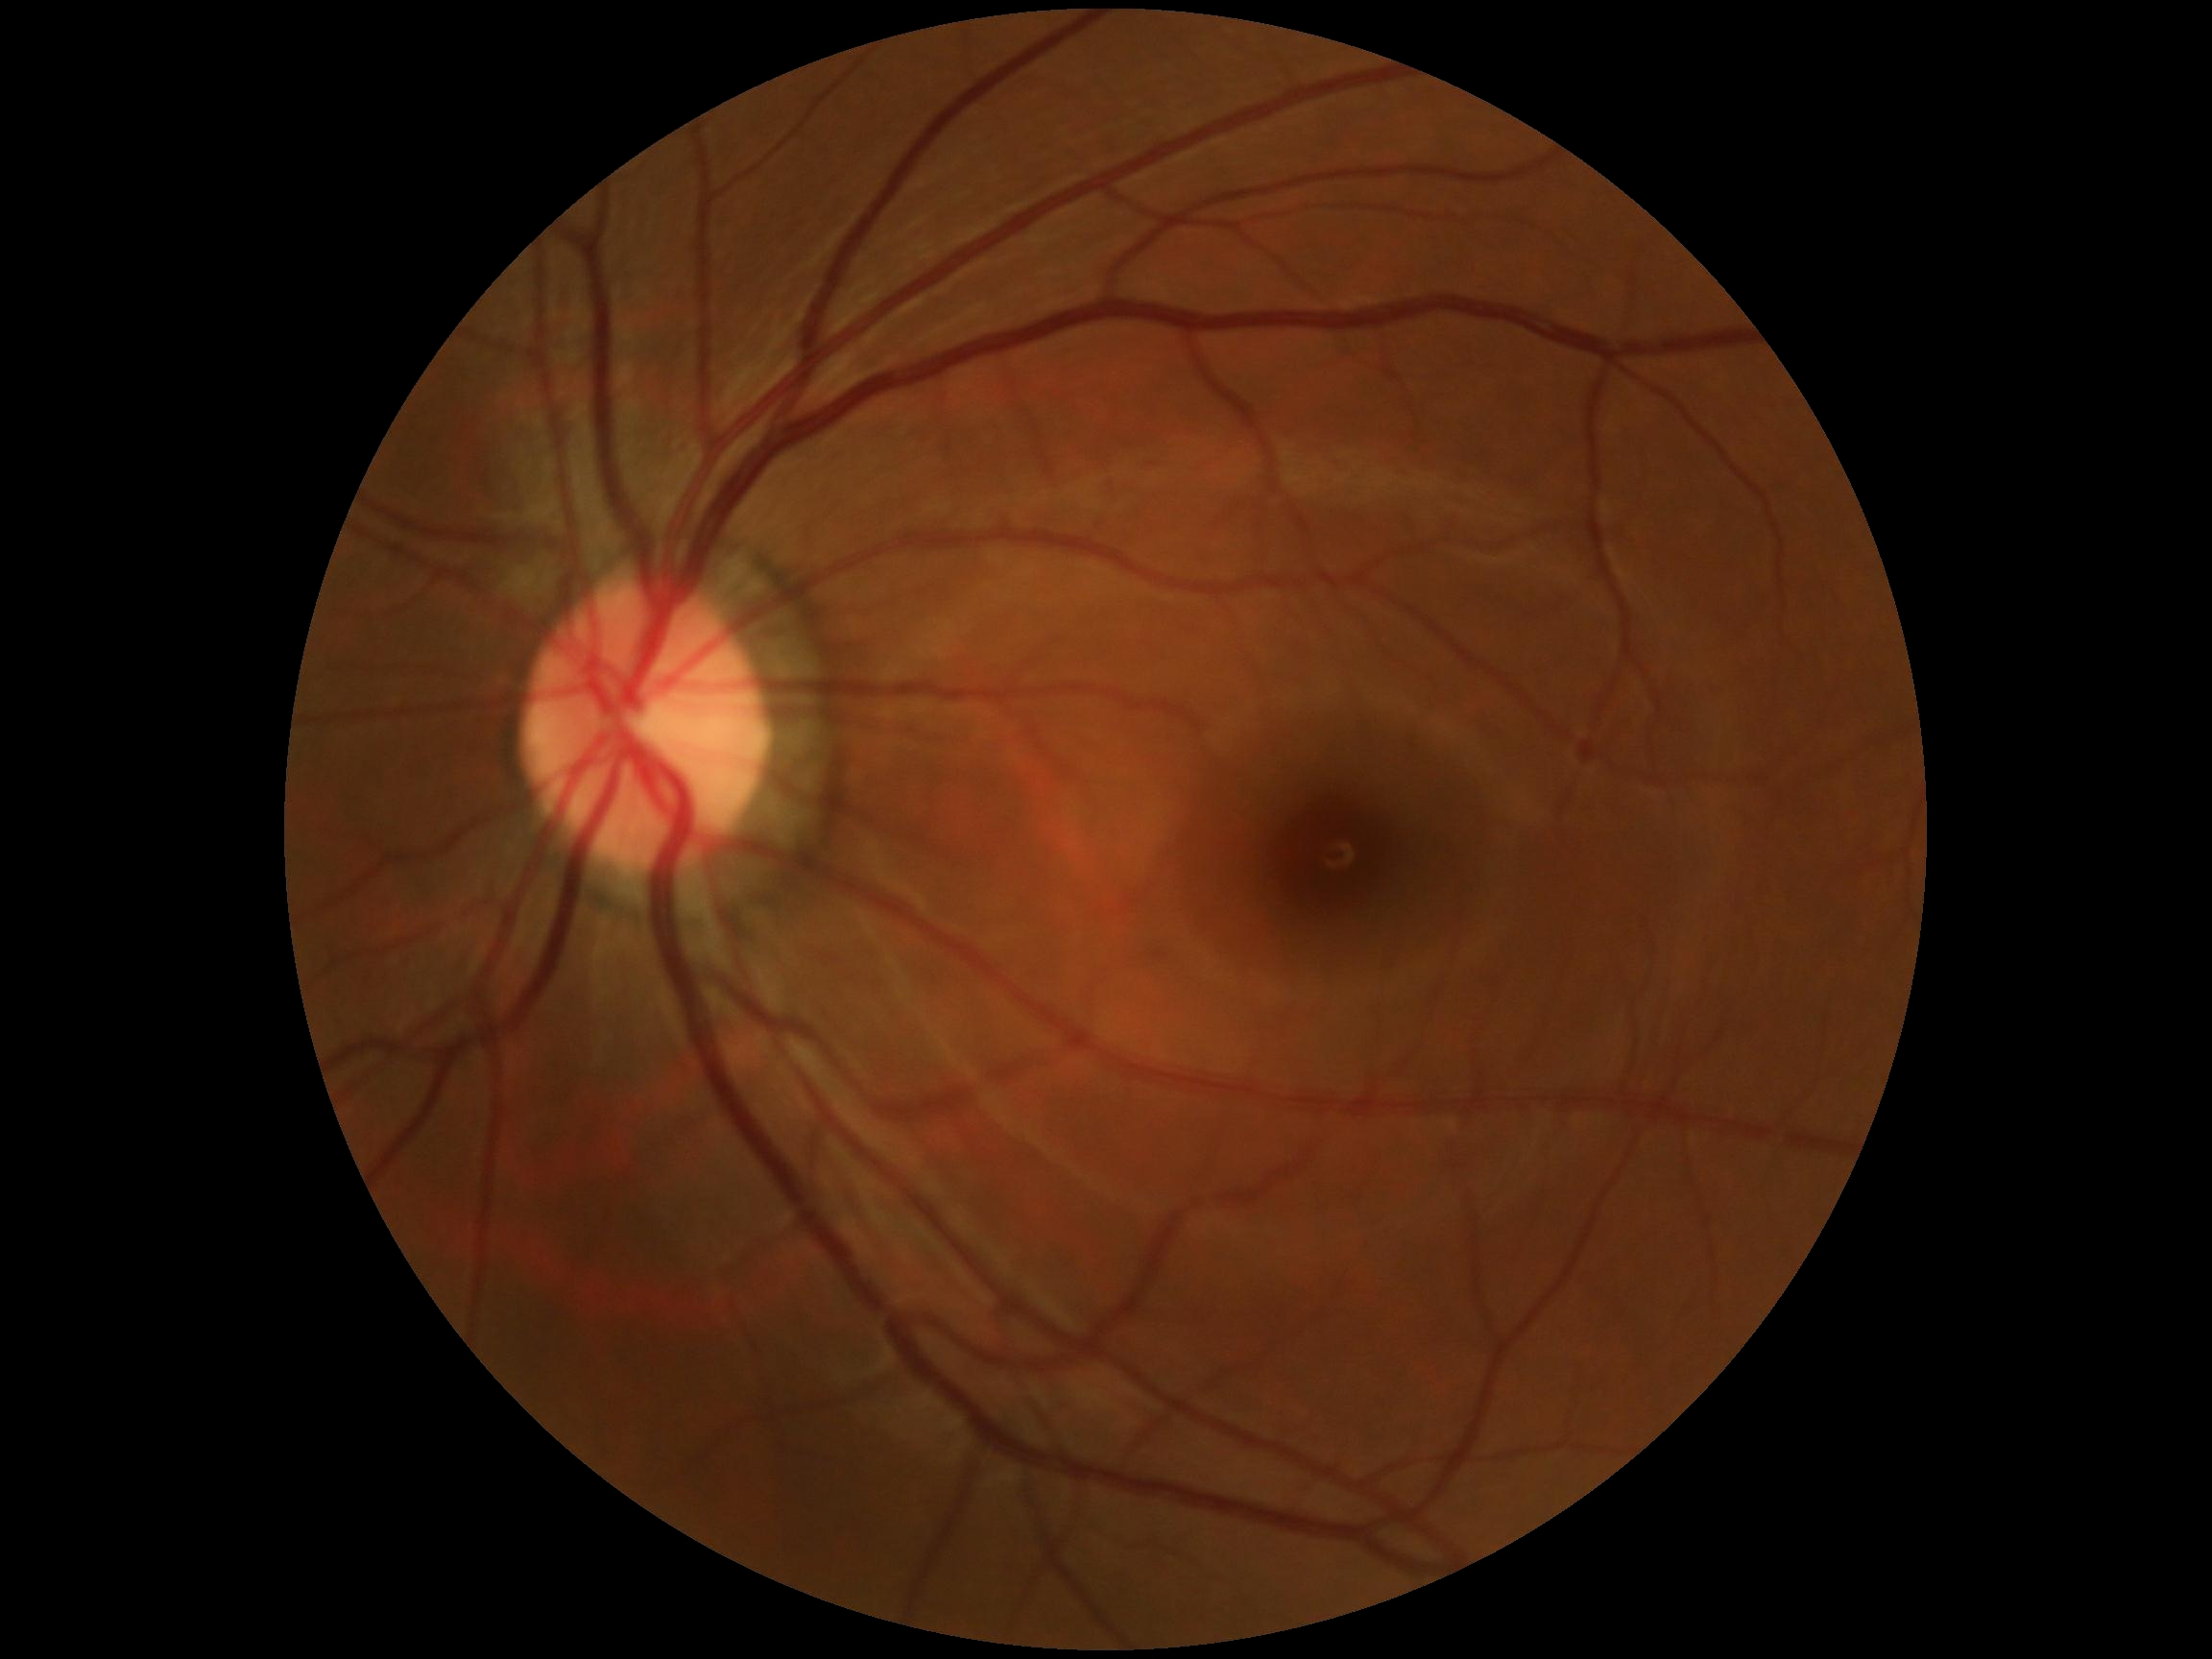

DR stage = grade 0.